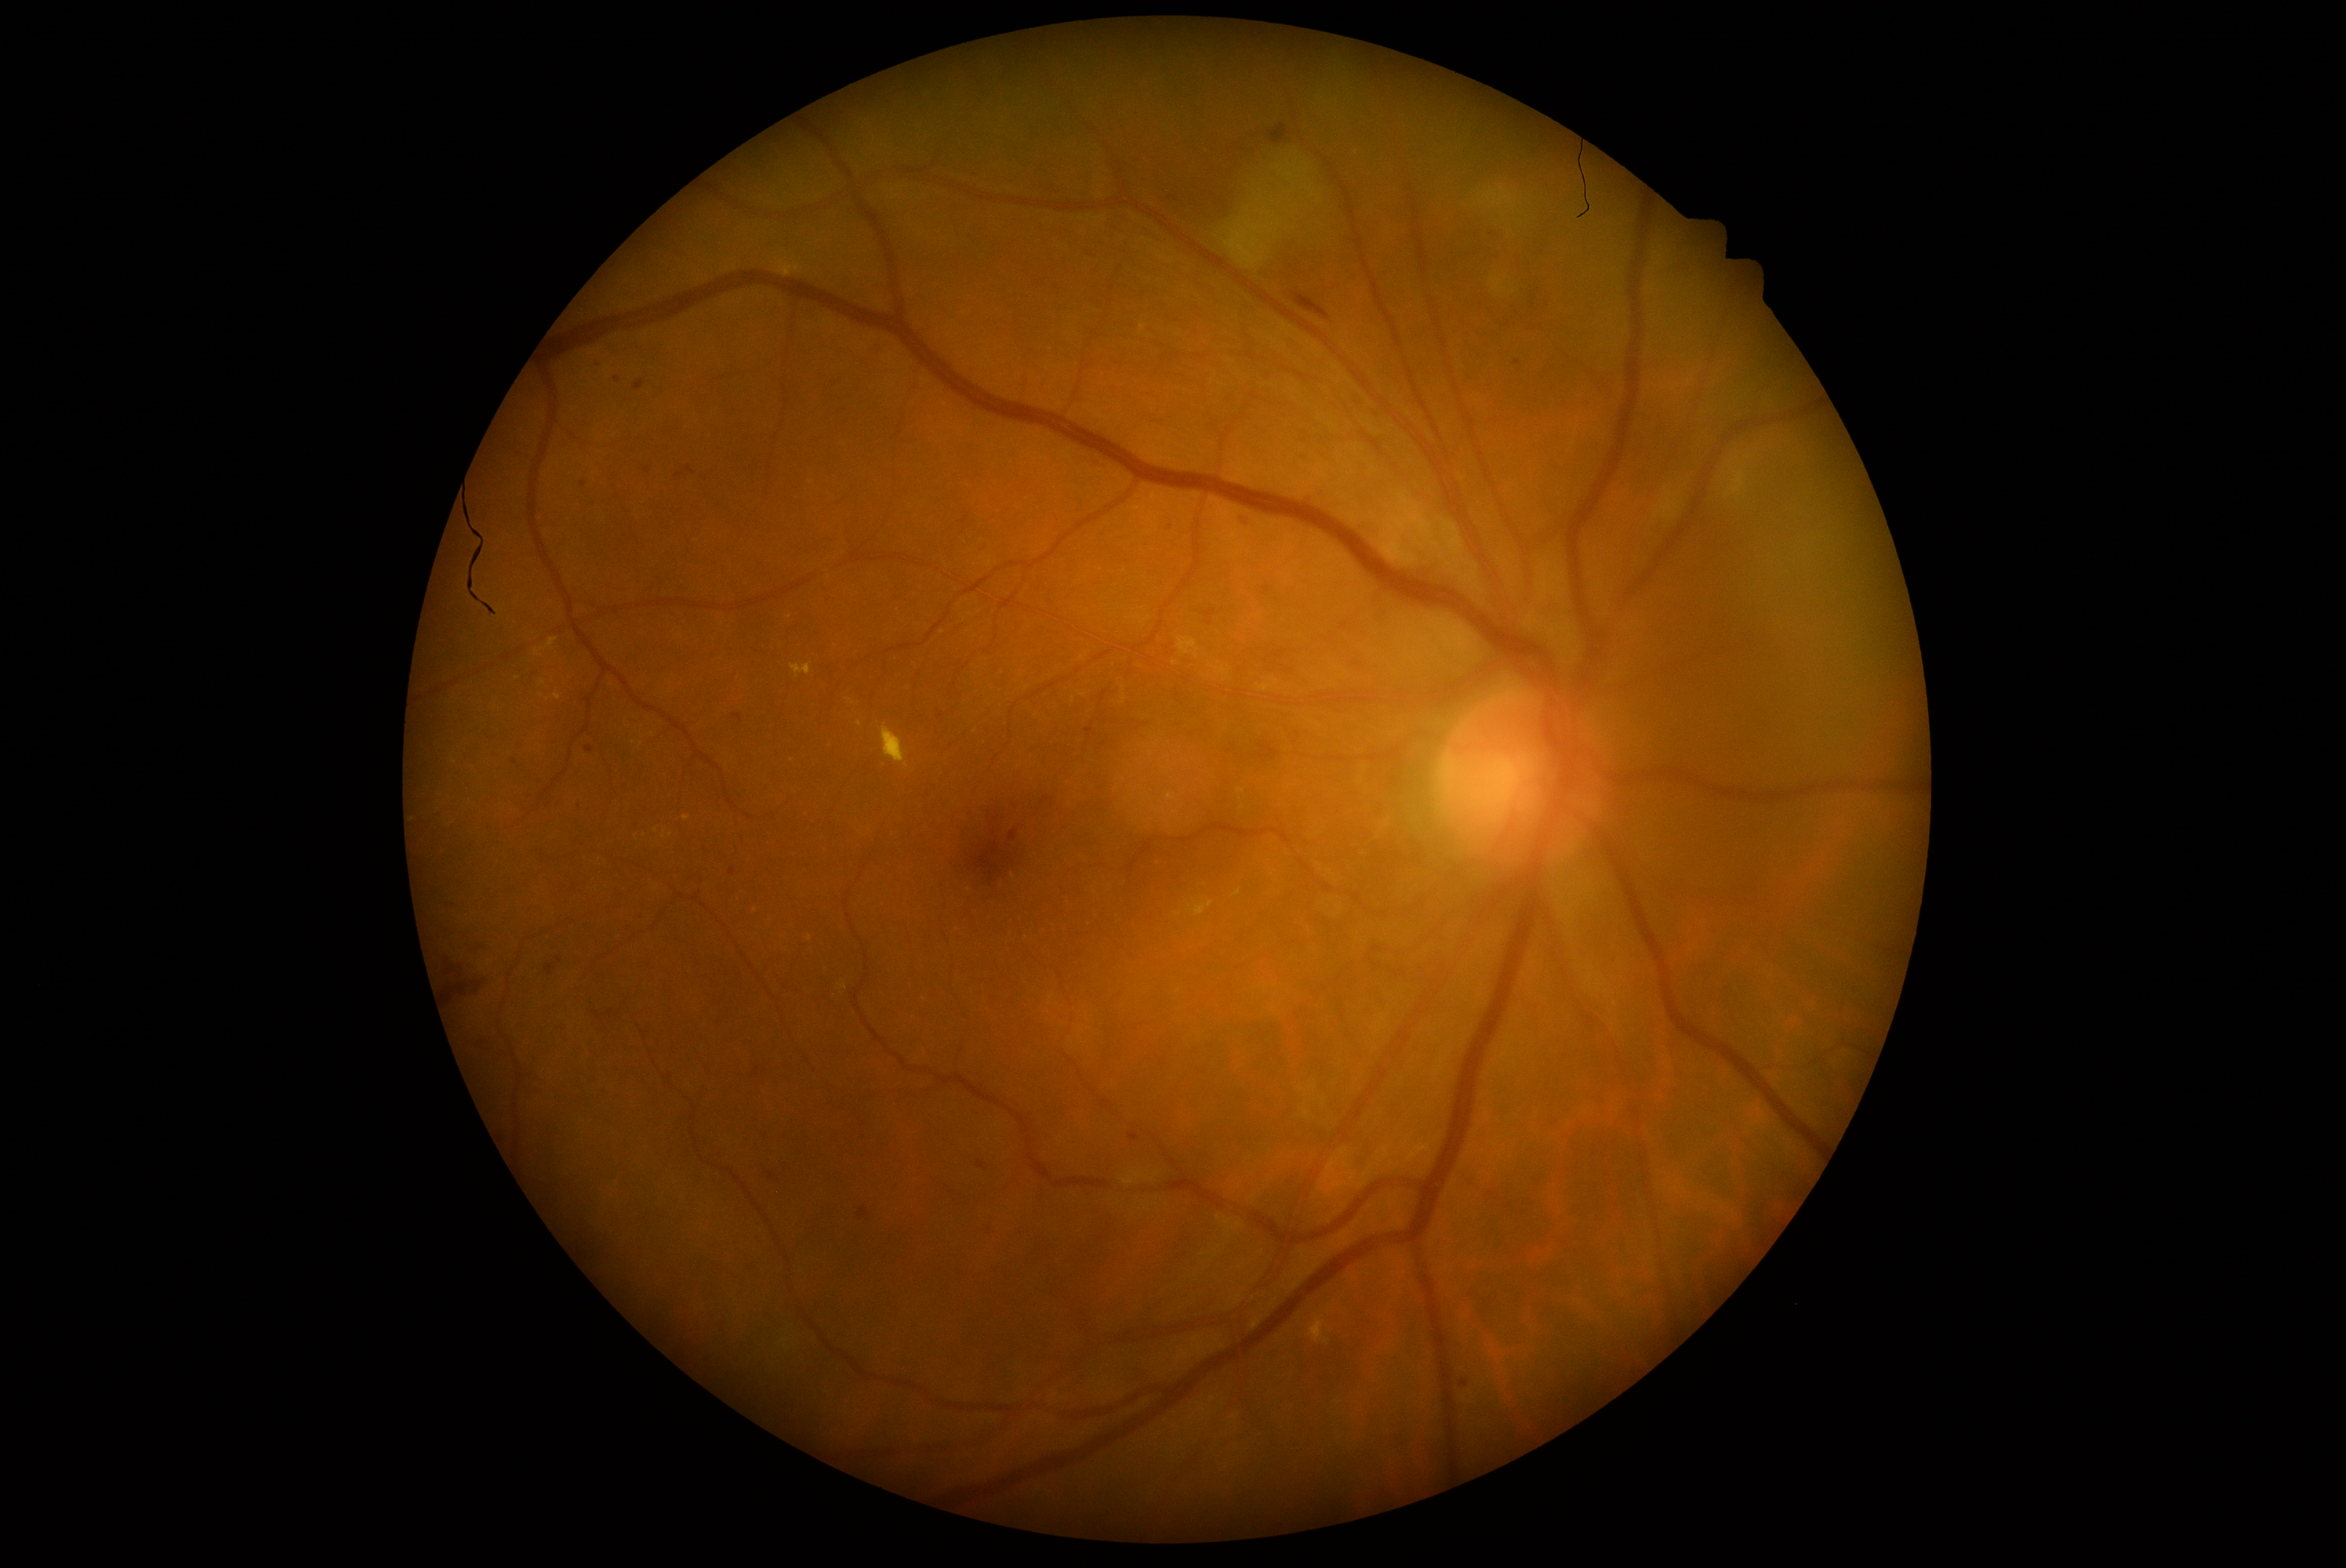 DR severity is grade 2 (moderate NPDR)
Representative lesions:
HEs: bbox=(443, 970, 487, 1018); bbox=(1291, 292, 1331, 319); bbox=(1266, 125, 1291, 145)
SEs: bbox=(1178, 636, 1200, 658); bbox=(1492, 278, 1505, 294); bbox=(1219, 147, 1337, 274); bbox=(1478, 186, 1517, 212)
MAs (subset): bbox=(730, 868, 736, 876); bbox=(860, 1210, 868, 1218); bbox=(1235, 514, 1247, 528); bbox=(1128, 1134, 1139, 1142); bbox=(1461, 1381, 1469, 1388); bbox=(686, 466, 695, 476); bbox=(937, 711, 945, 720); bbox=(547, 964, 556, 976)
MAs (small, approximate centers) near (560,960); (1492,234); (670,1076); (541,784); (514,763); (678,476); (583,484)
EXs (subset): bbox=(1186, 899, 1215, 918); bbox=(554, 694, 561, 702); bbox=(548, 637, 557, 652); bbox=(777, 260, 802, 278); bbox=(1233, 891, 1241, 896); bbox=(879, 725, 909, 768); bbox=(534, 648, 547, 658); bbox=(1727, 473, 1748, 498); bbox=(791, 662, 812, 677); bbox=(1252, 1321, 1262, 1330); bbox=(1310, 1319, 1324, 1343)
EXs (small, approximate centers) near (548,700); (543,683); (516,678)